2352 x 1568 pixels
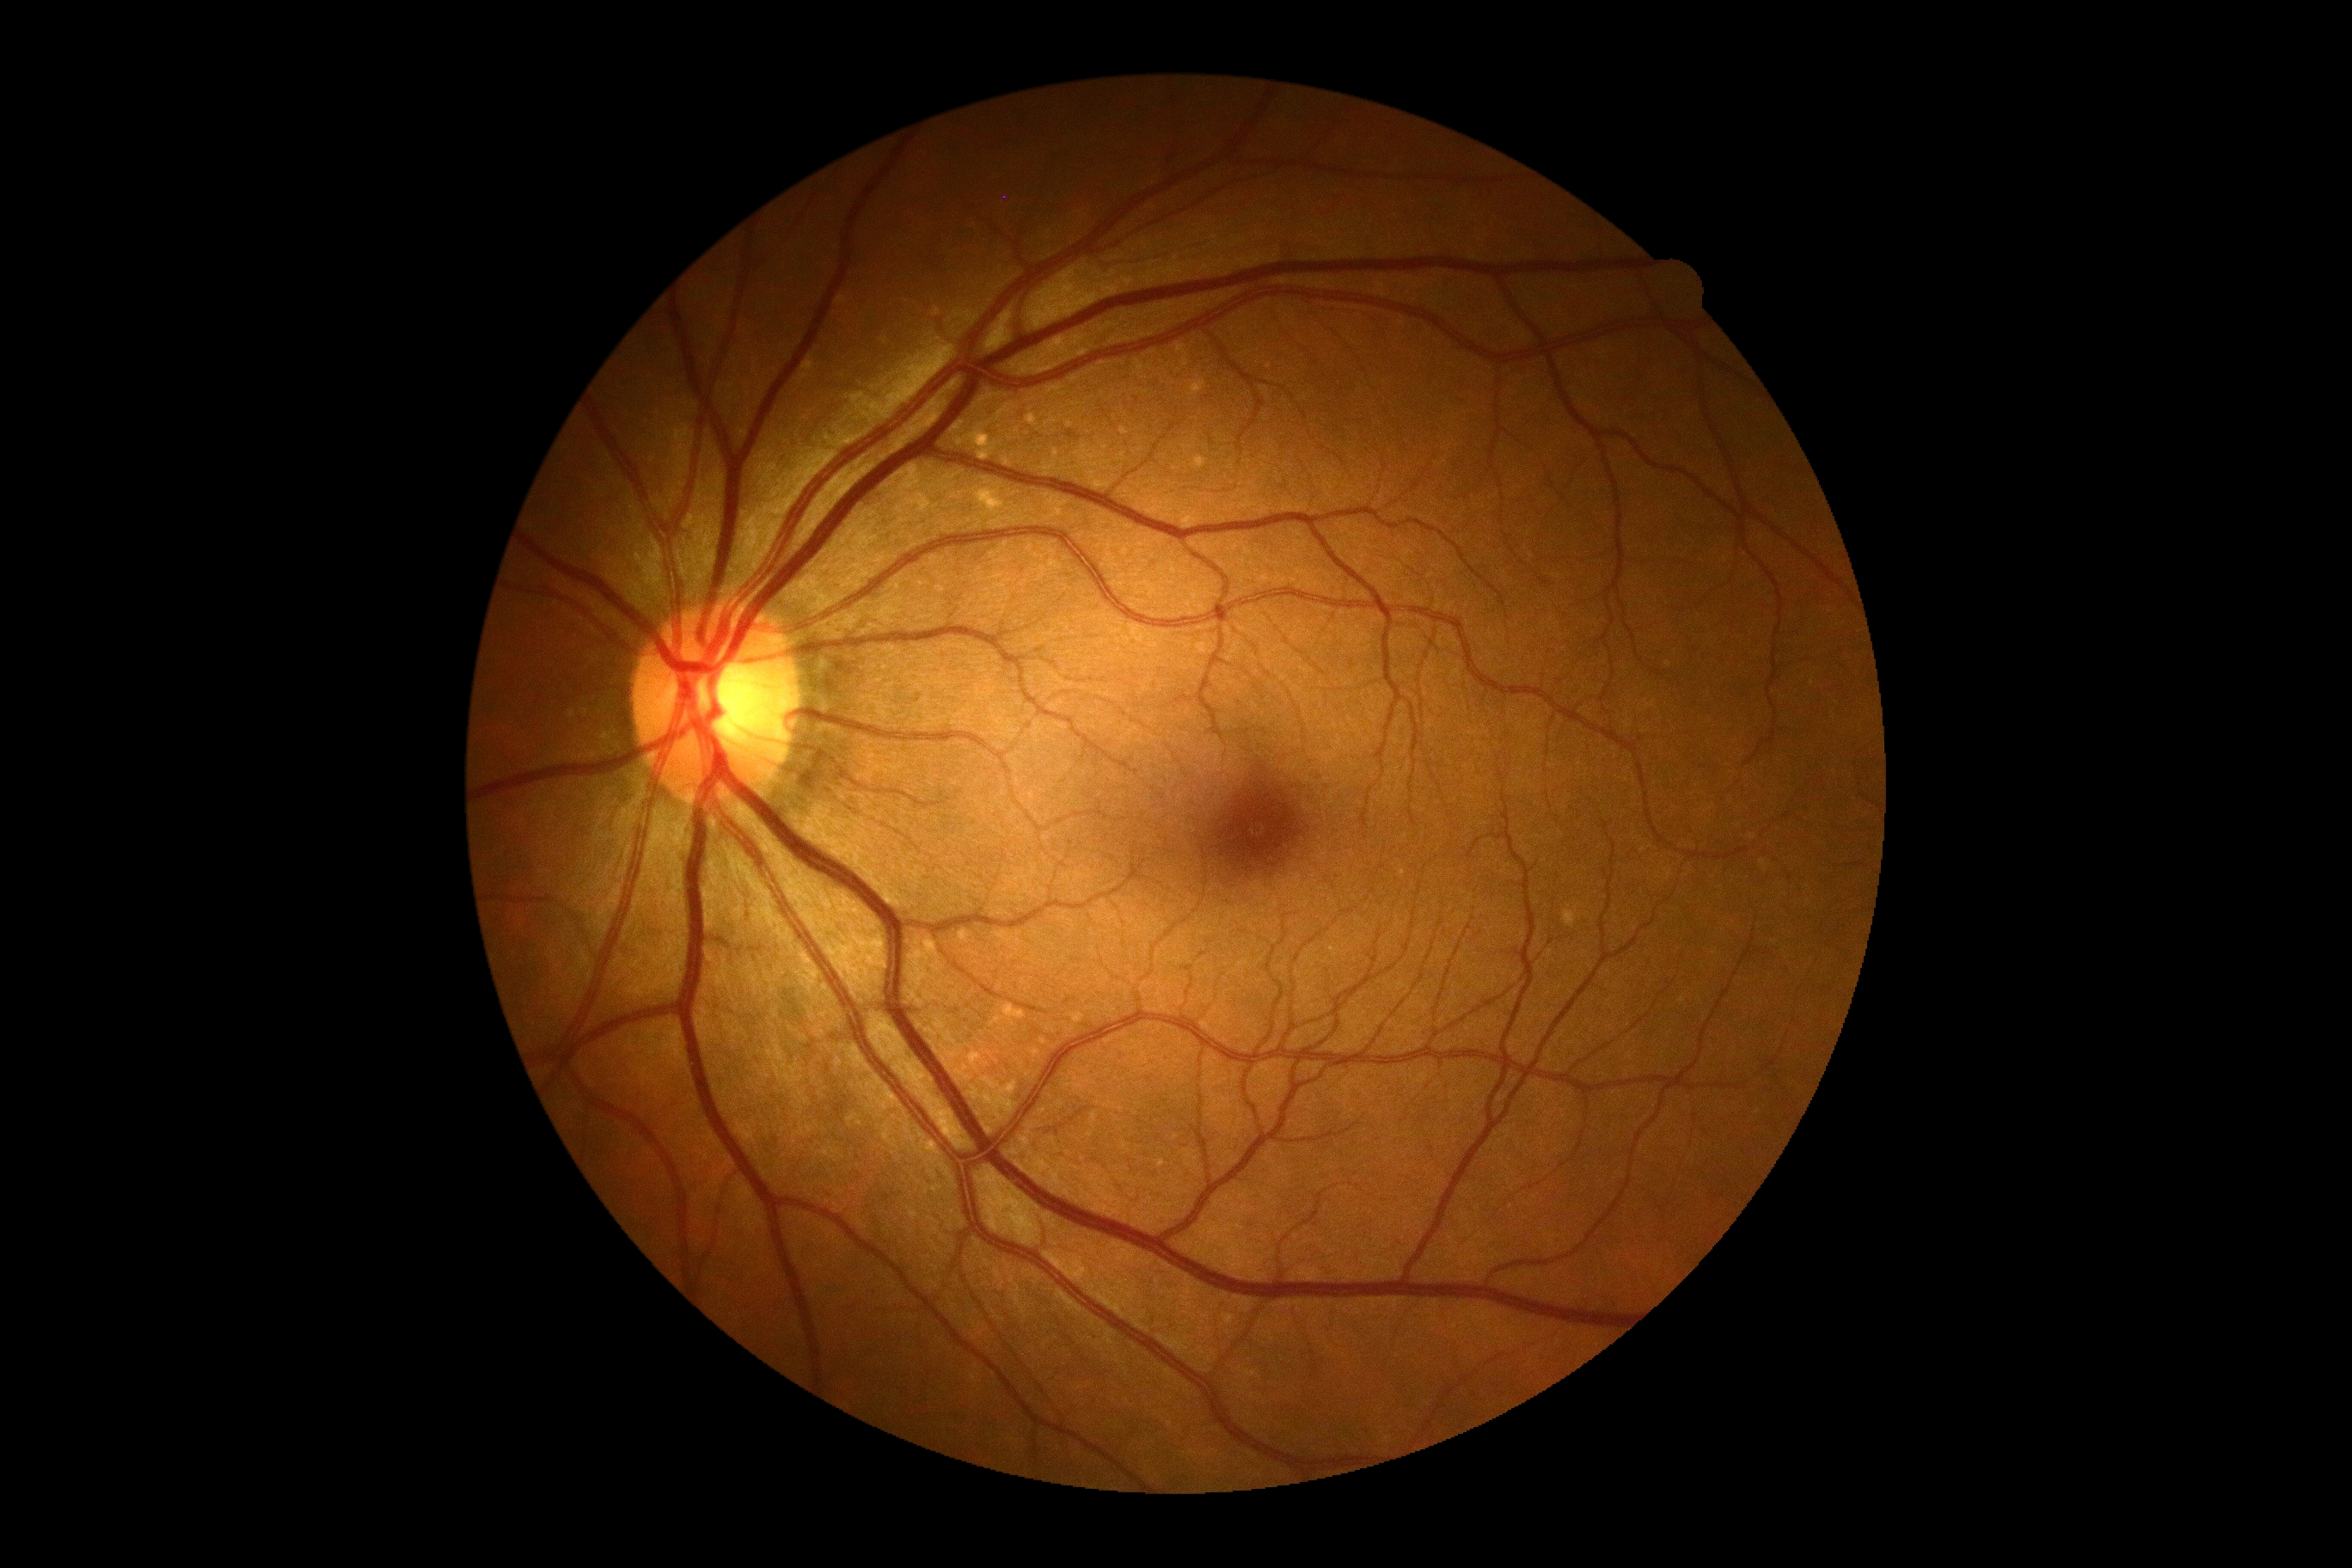

Diabetic retinopathy (DR) is 0/4.